CFP
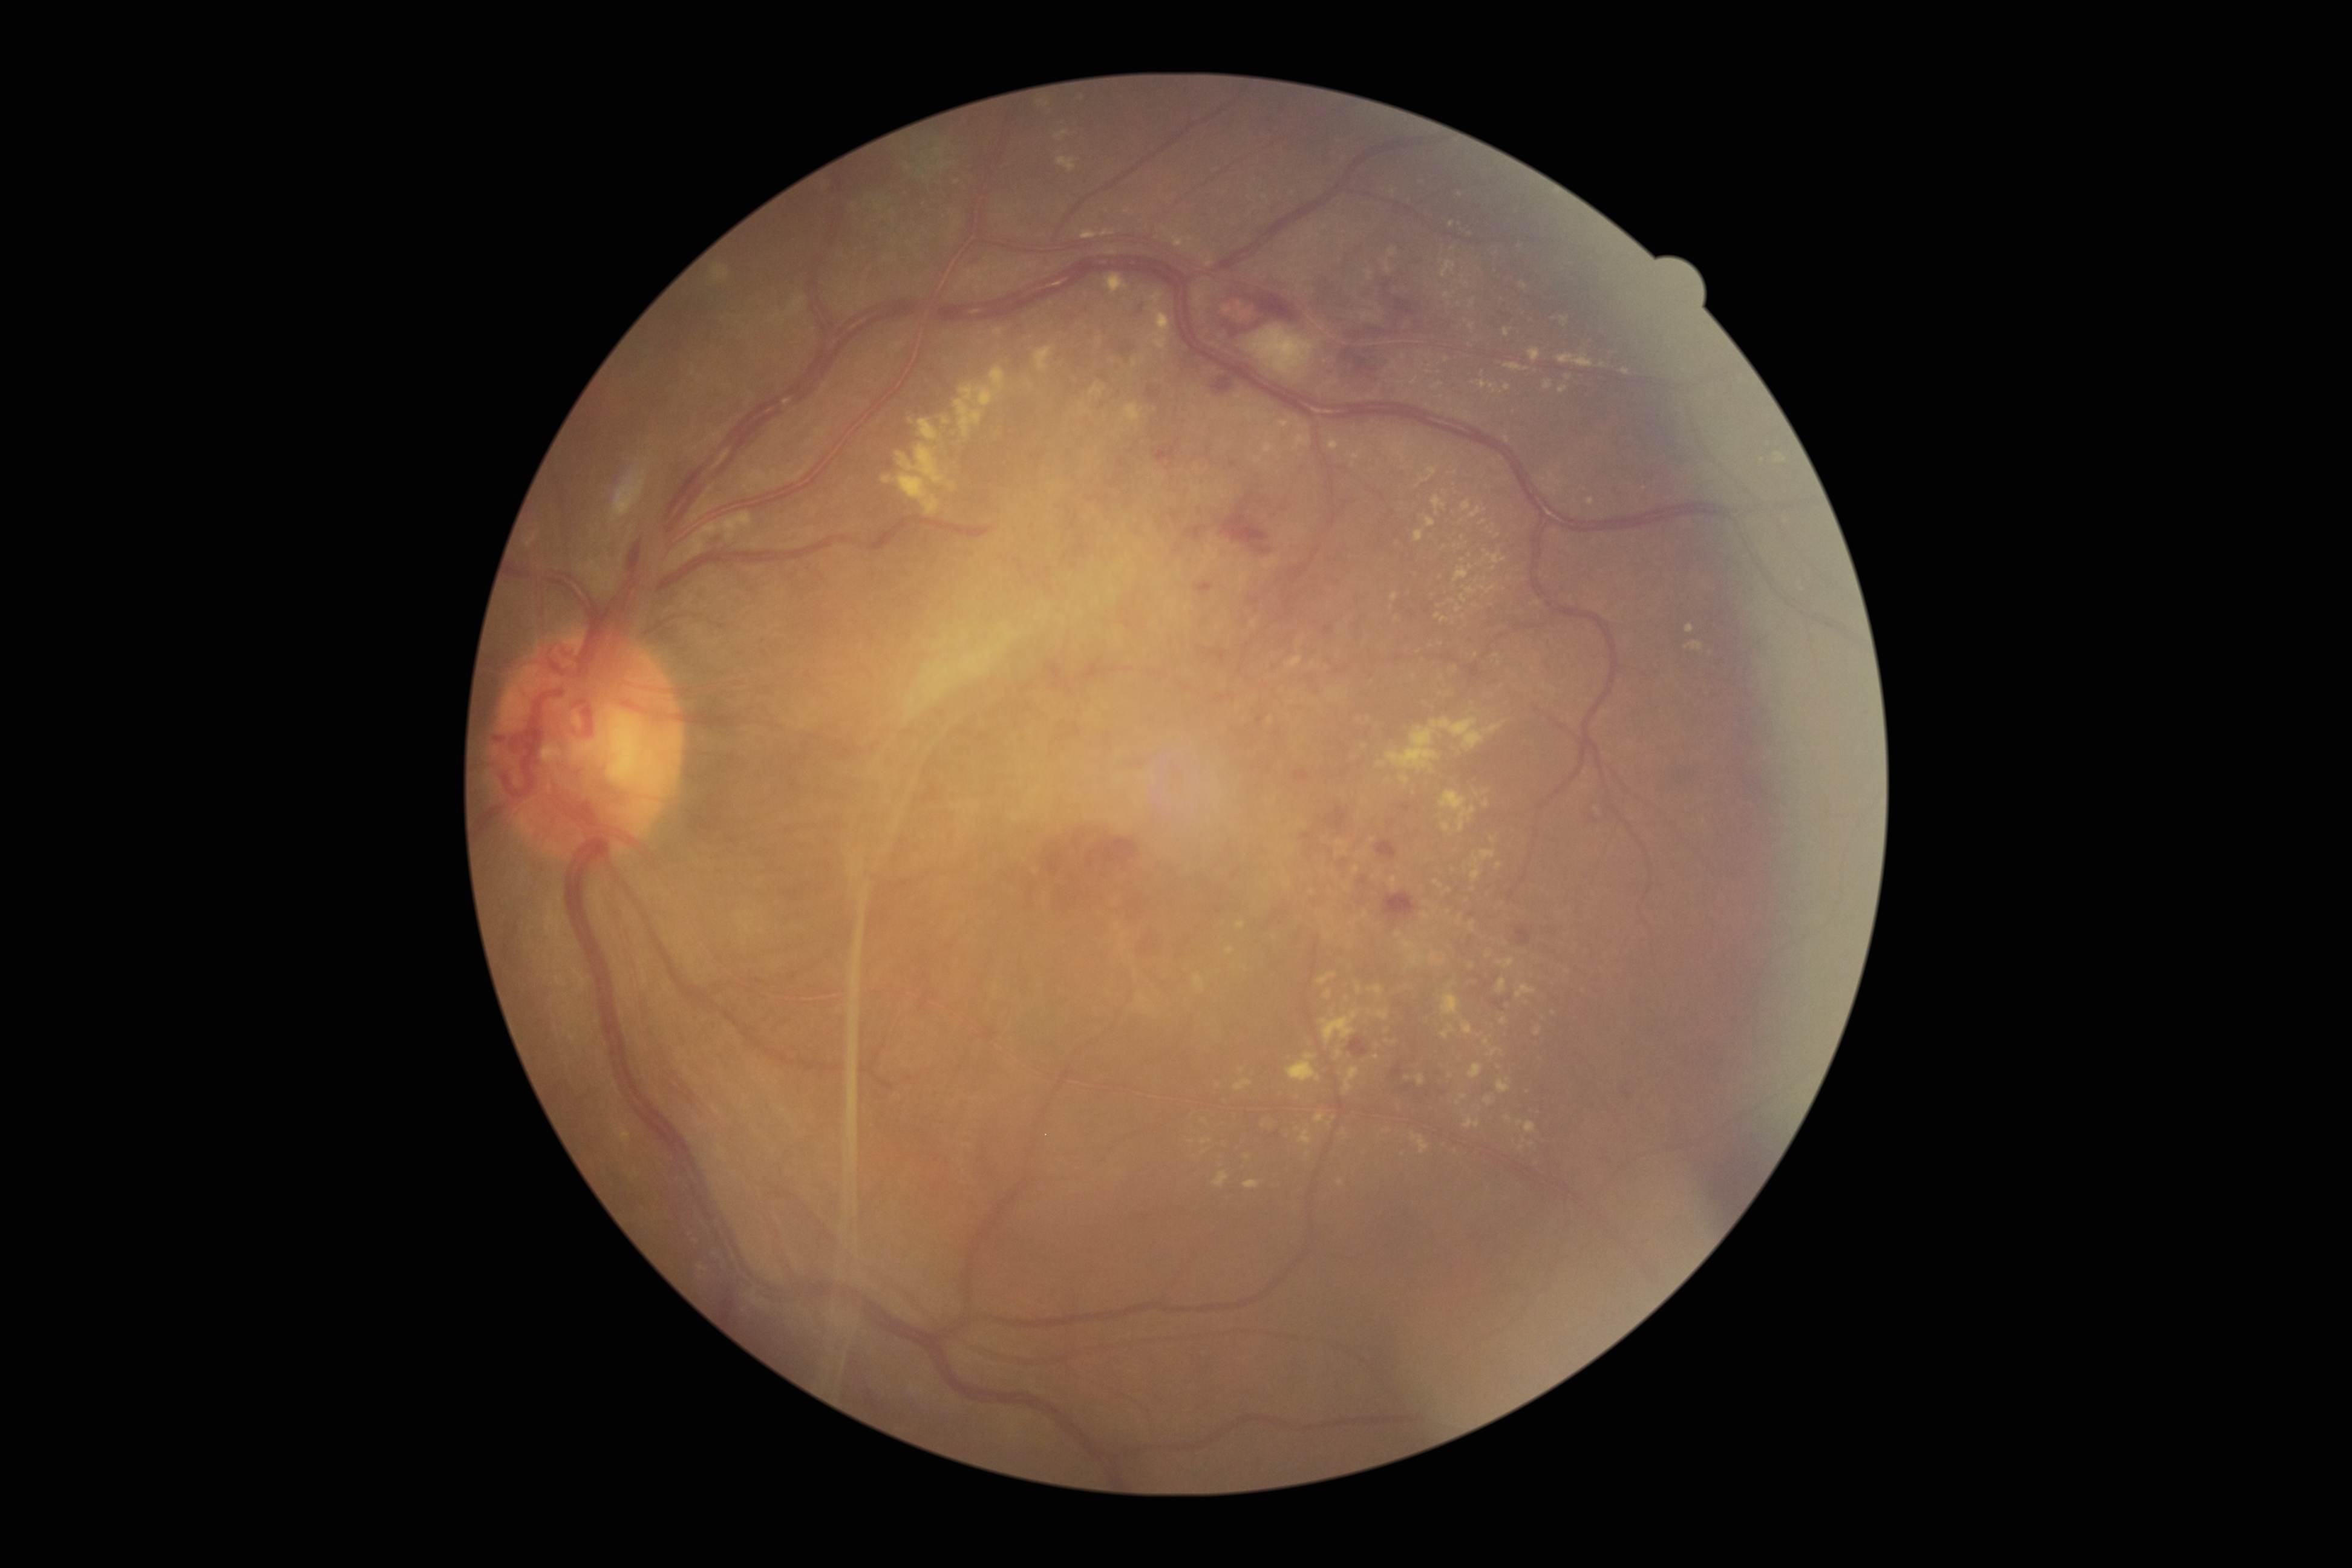

Diabetic retinopathy (DR) is grade 4 (PDR) — neovascularization and/or vitreous/pre-retinal hemorrhage
Lesions identified (partial list):
• hard exudates (EXs) (subset): 1478:381:1497:395; 1503:327:1511:338; 1440:618:1448:622; 1486:1047:1503:1056; 1264:442:1277:456; 1344:1067:1359:1093; 1244:1180:1259:1187; 1315:1114:1325:1122; 885:443:955:516; 1392:362:1399:370; 1226:947:1235:954; 1235:1080:1254:1091
• Small EXs approximately at Point(1365, 745); Point(1448, 912); Point(1455, 1151); Point(1440, 643); Point(1246, 970); Point(1507, 439); Point(1341, 1183); Point(1498, 536)
• hemorrhages (HEs) (subset): 1392:1065:1403:1079; 1087:839:1139:868; 1194:581:1215:597; 1323:626:1333:635; 1325:840:1335:866; 1369:275:1423:330; 1294:770:1311:782; 1340:851:1358:873; 1515:926:1531:946; 492:734:503:740; 1494:1000:1503:1011; 1376:841:1397:860; 1350:612:1365:644; 1146:387:1161:400; 1044:659:1056:678; 1382:891:1417:923
• Small HEs approximately at Point(1175, 515); Point(1247, 500)